Wide-field contact fundus photograph of an infant; acquired on the Phoenix ICON.
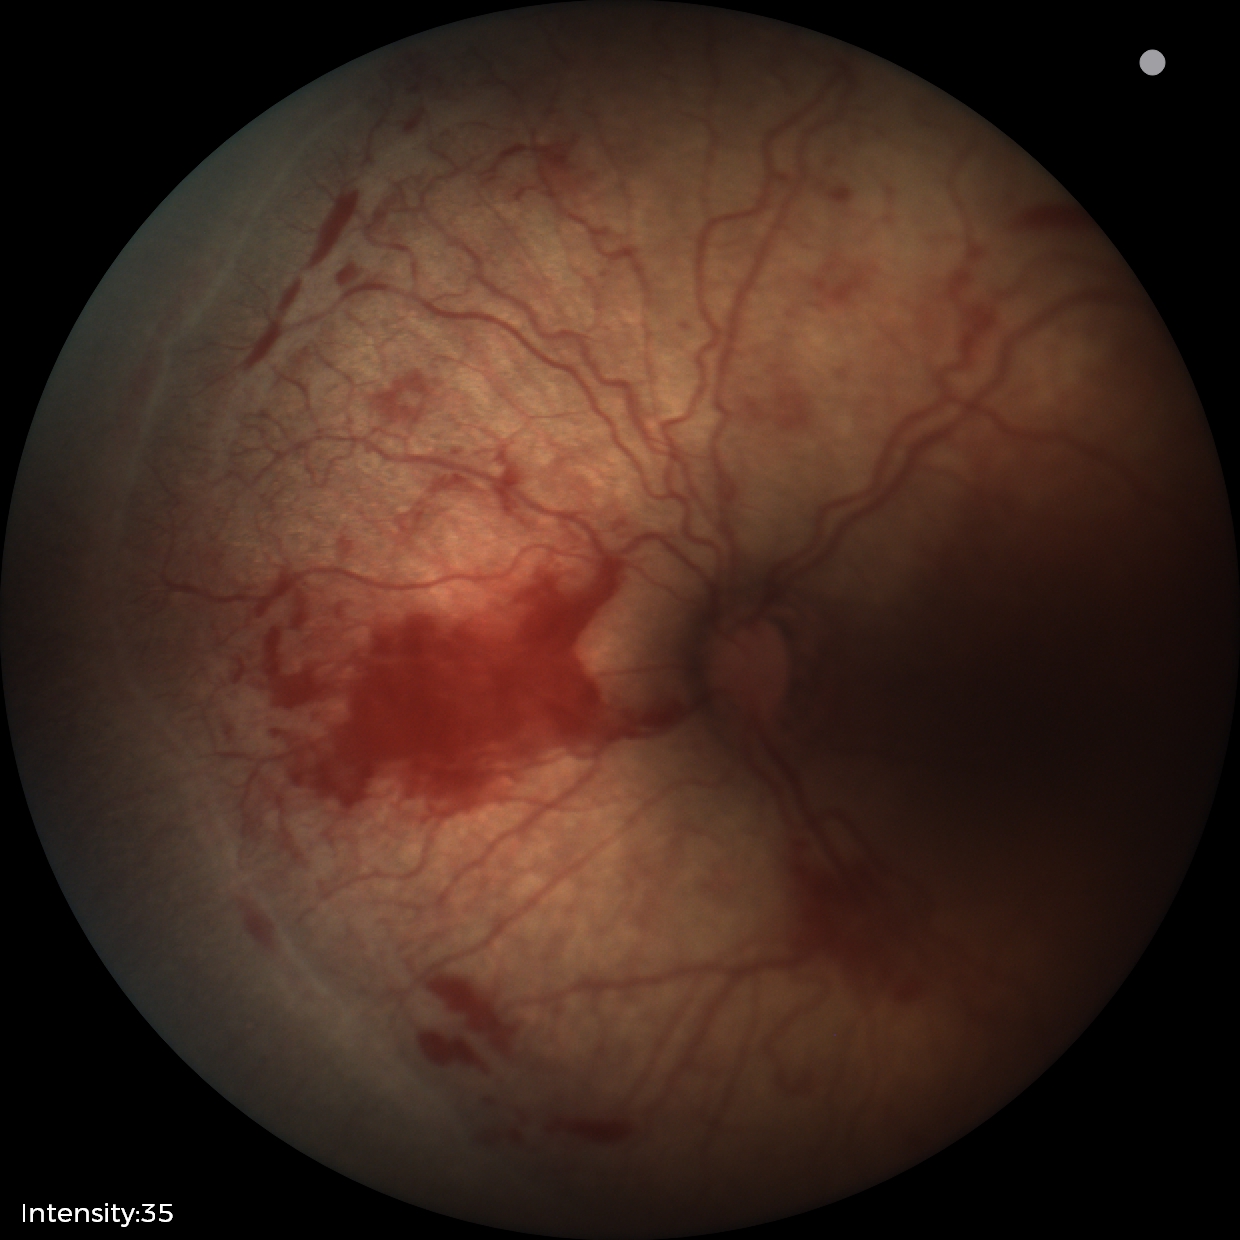

Impression: plus disease | retinopathy of prematurity stage 2 — ridge with height and width at the demarcation line.